FOV: 45 degrees
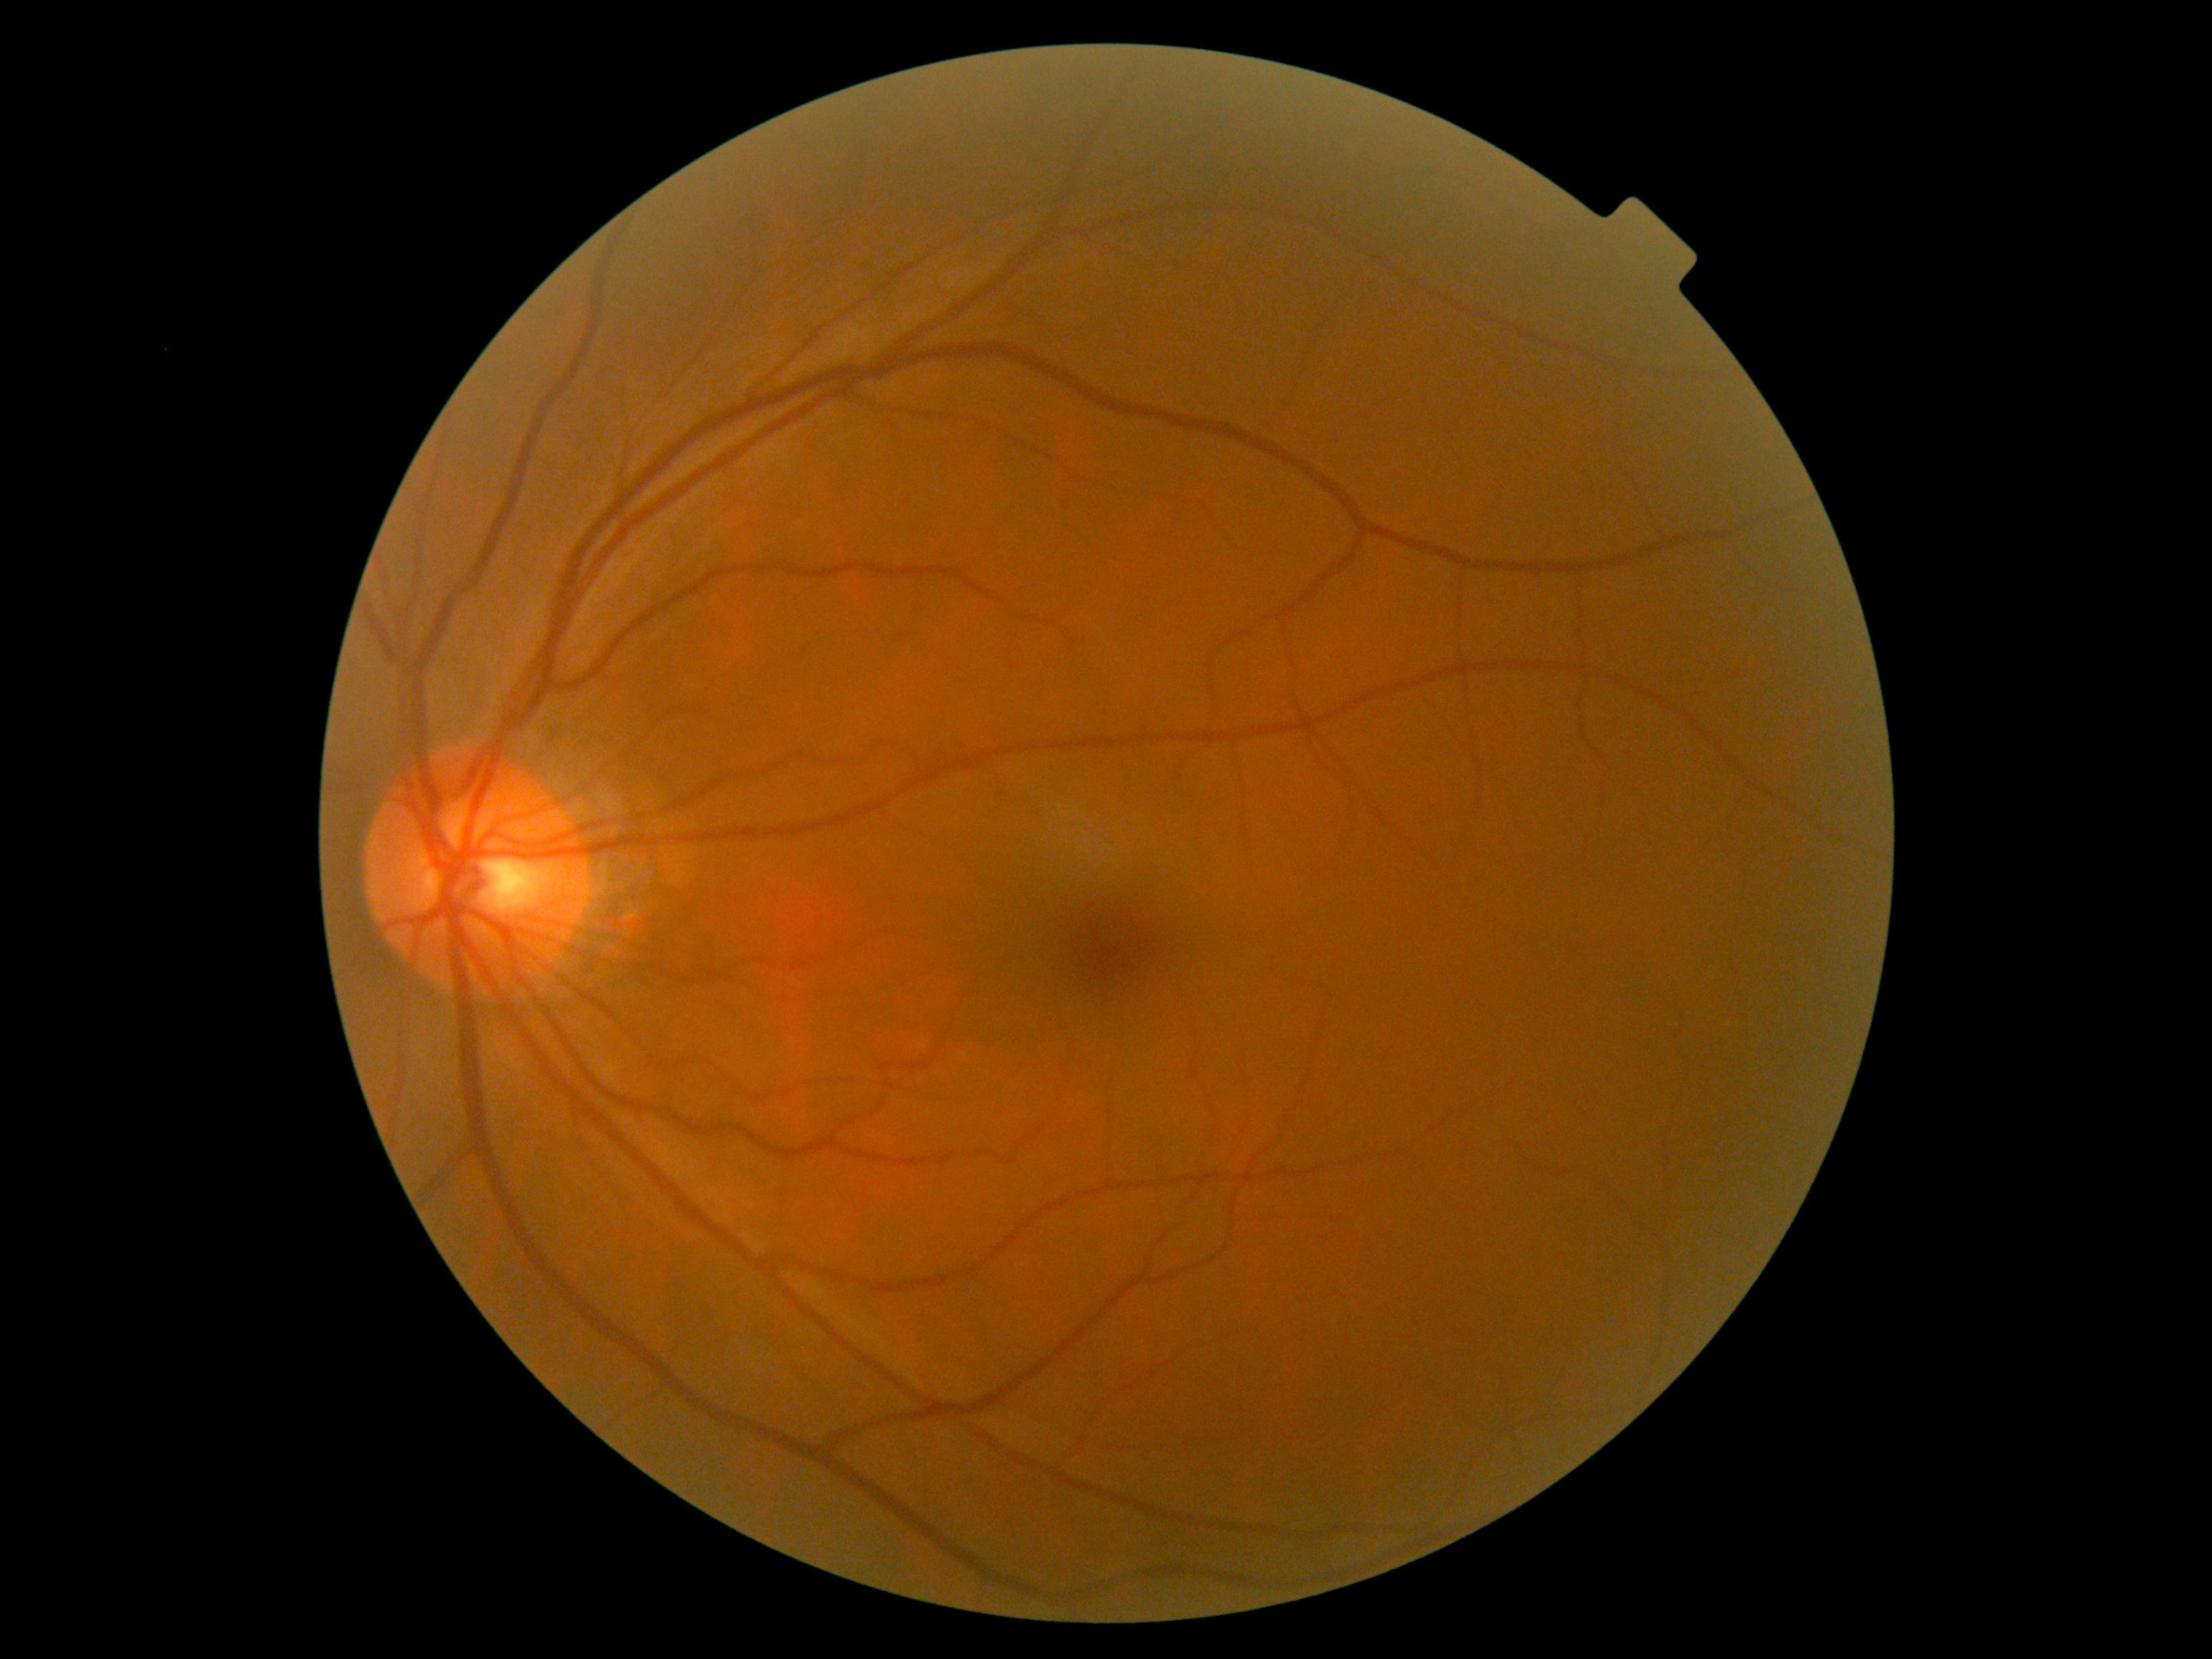 No DR findings. DR severity is no apparent diabetic retinopathy (grade 0).